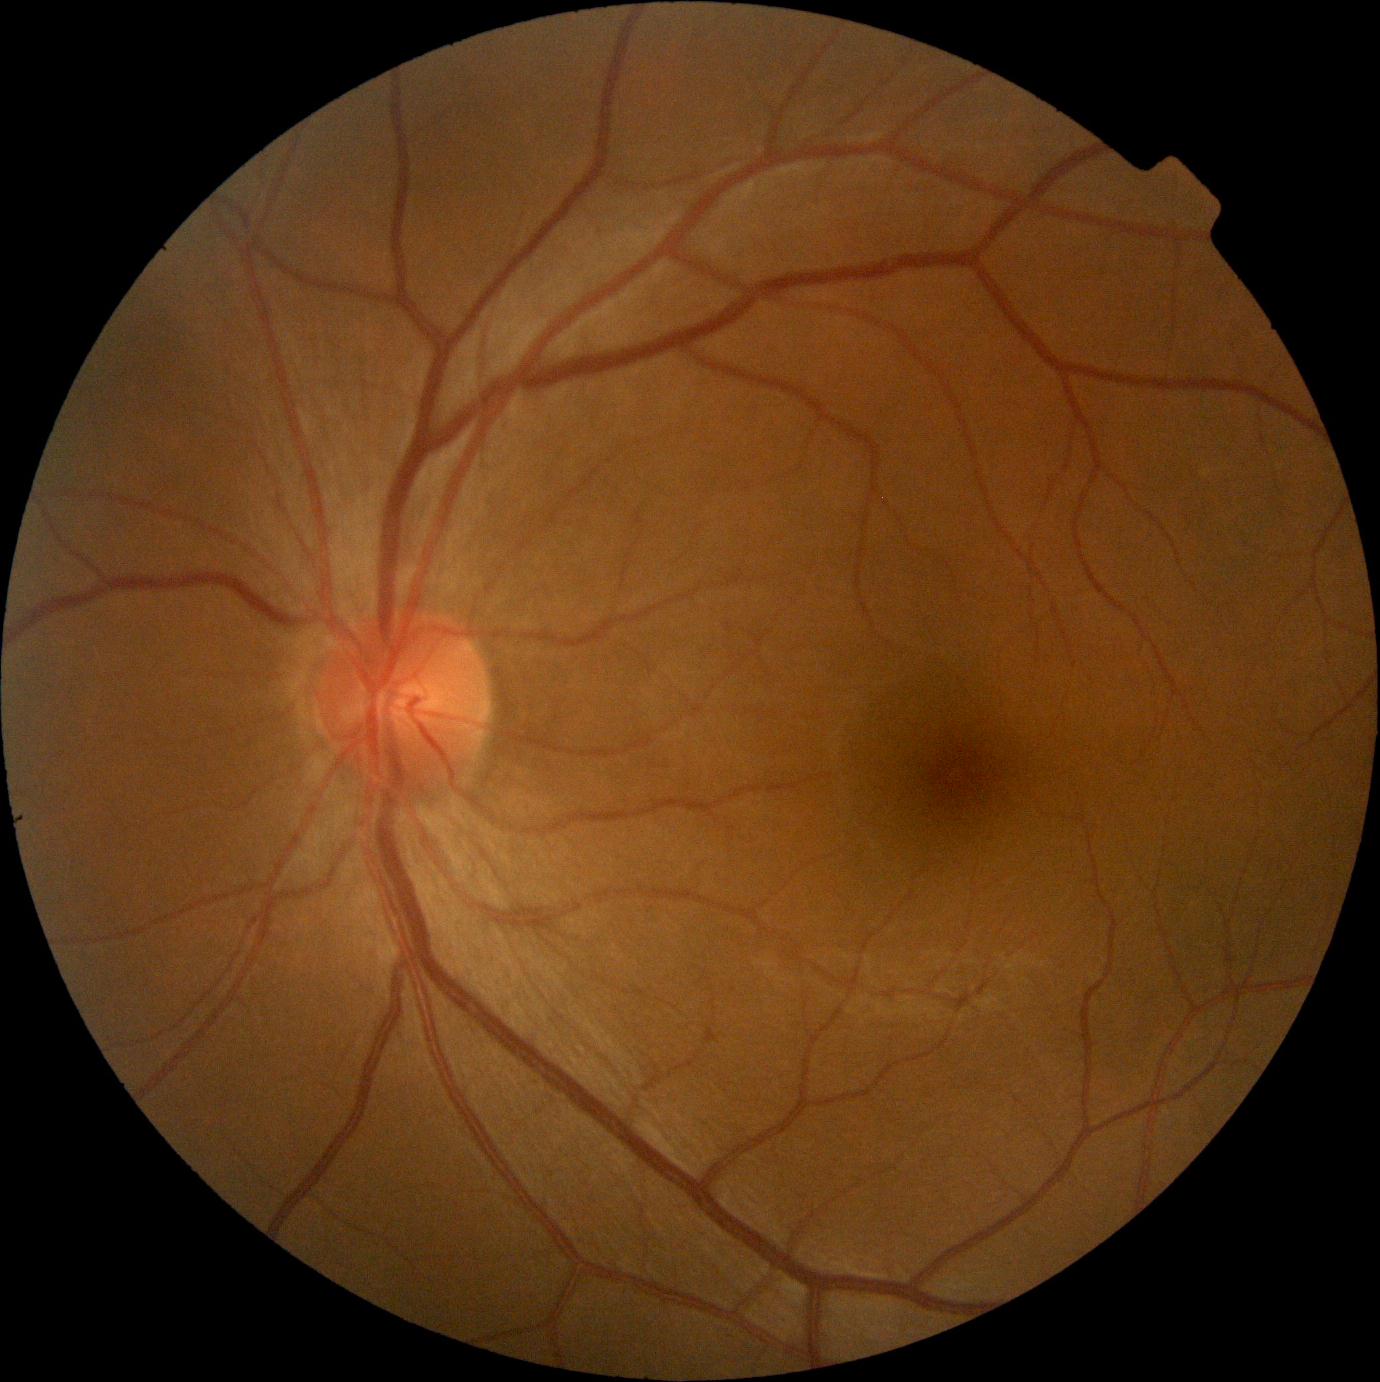

- diabetic retinopathy (DR): no apparent retinopathy (grade 0)